640 by 480 pixels · 130° field of view (Clarity RetCam 3) · RetCam wide-field infant fundus image:
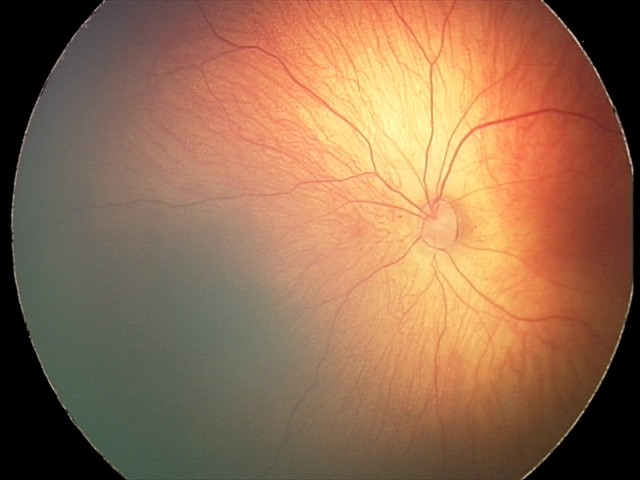 Diagnosis from this screening exam: retinal hemorrhages.